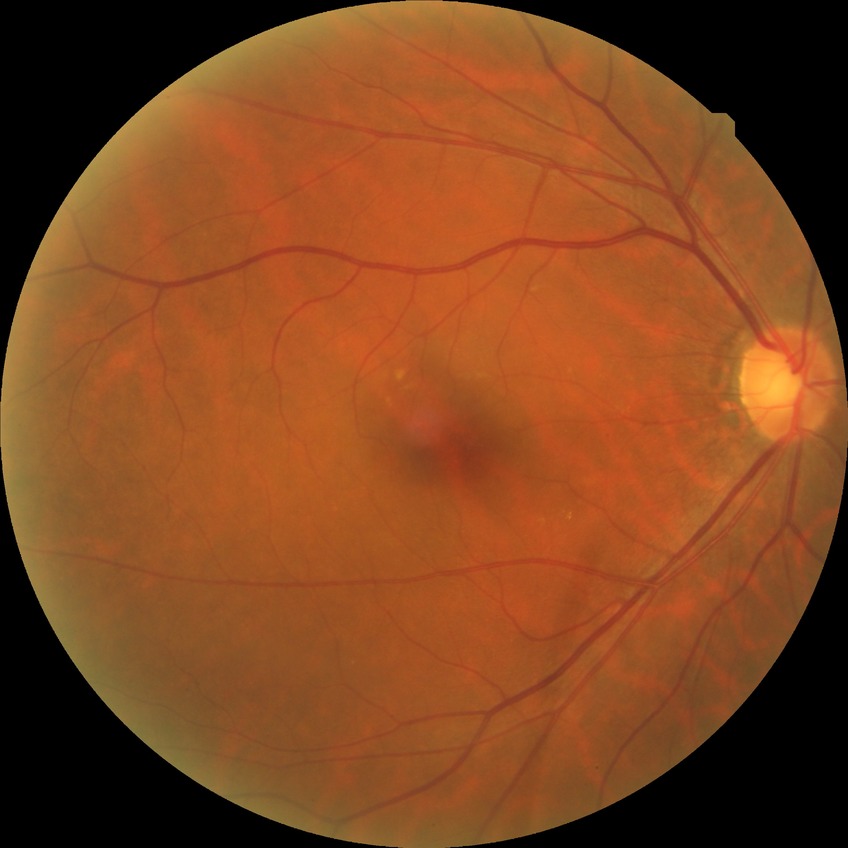

Diabetic retinopathy (DR): no diabetic retinopathy (NDR).